Retinal fundus photograph; Remidio smartphone fundus camera: 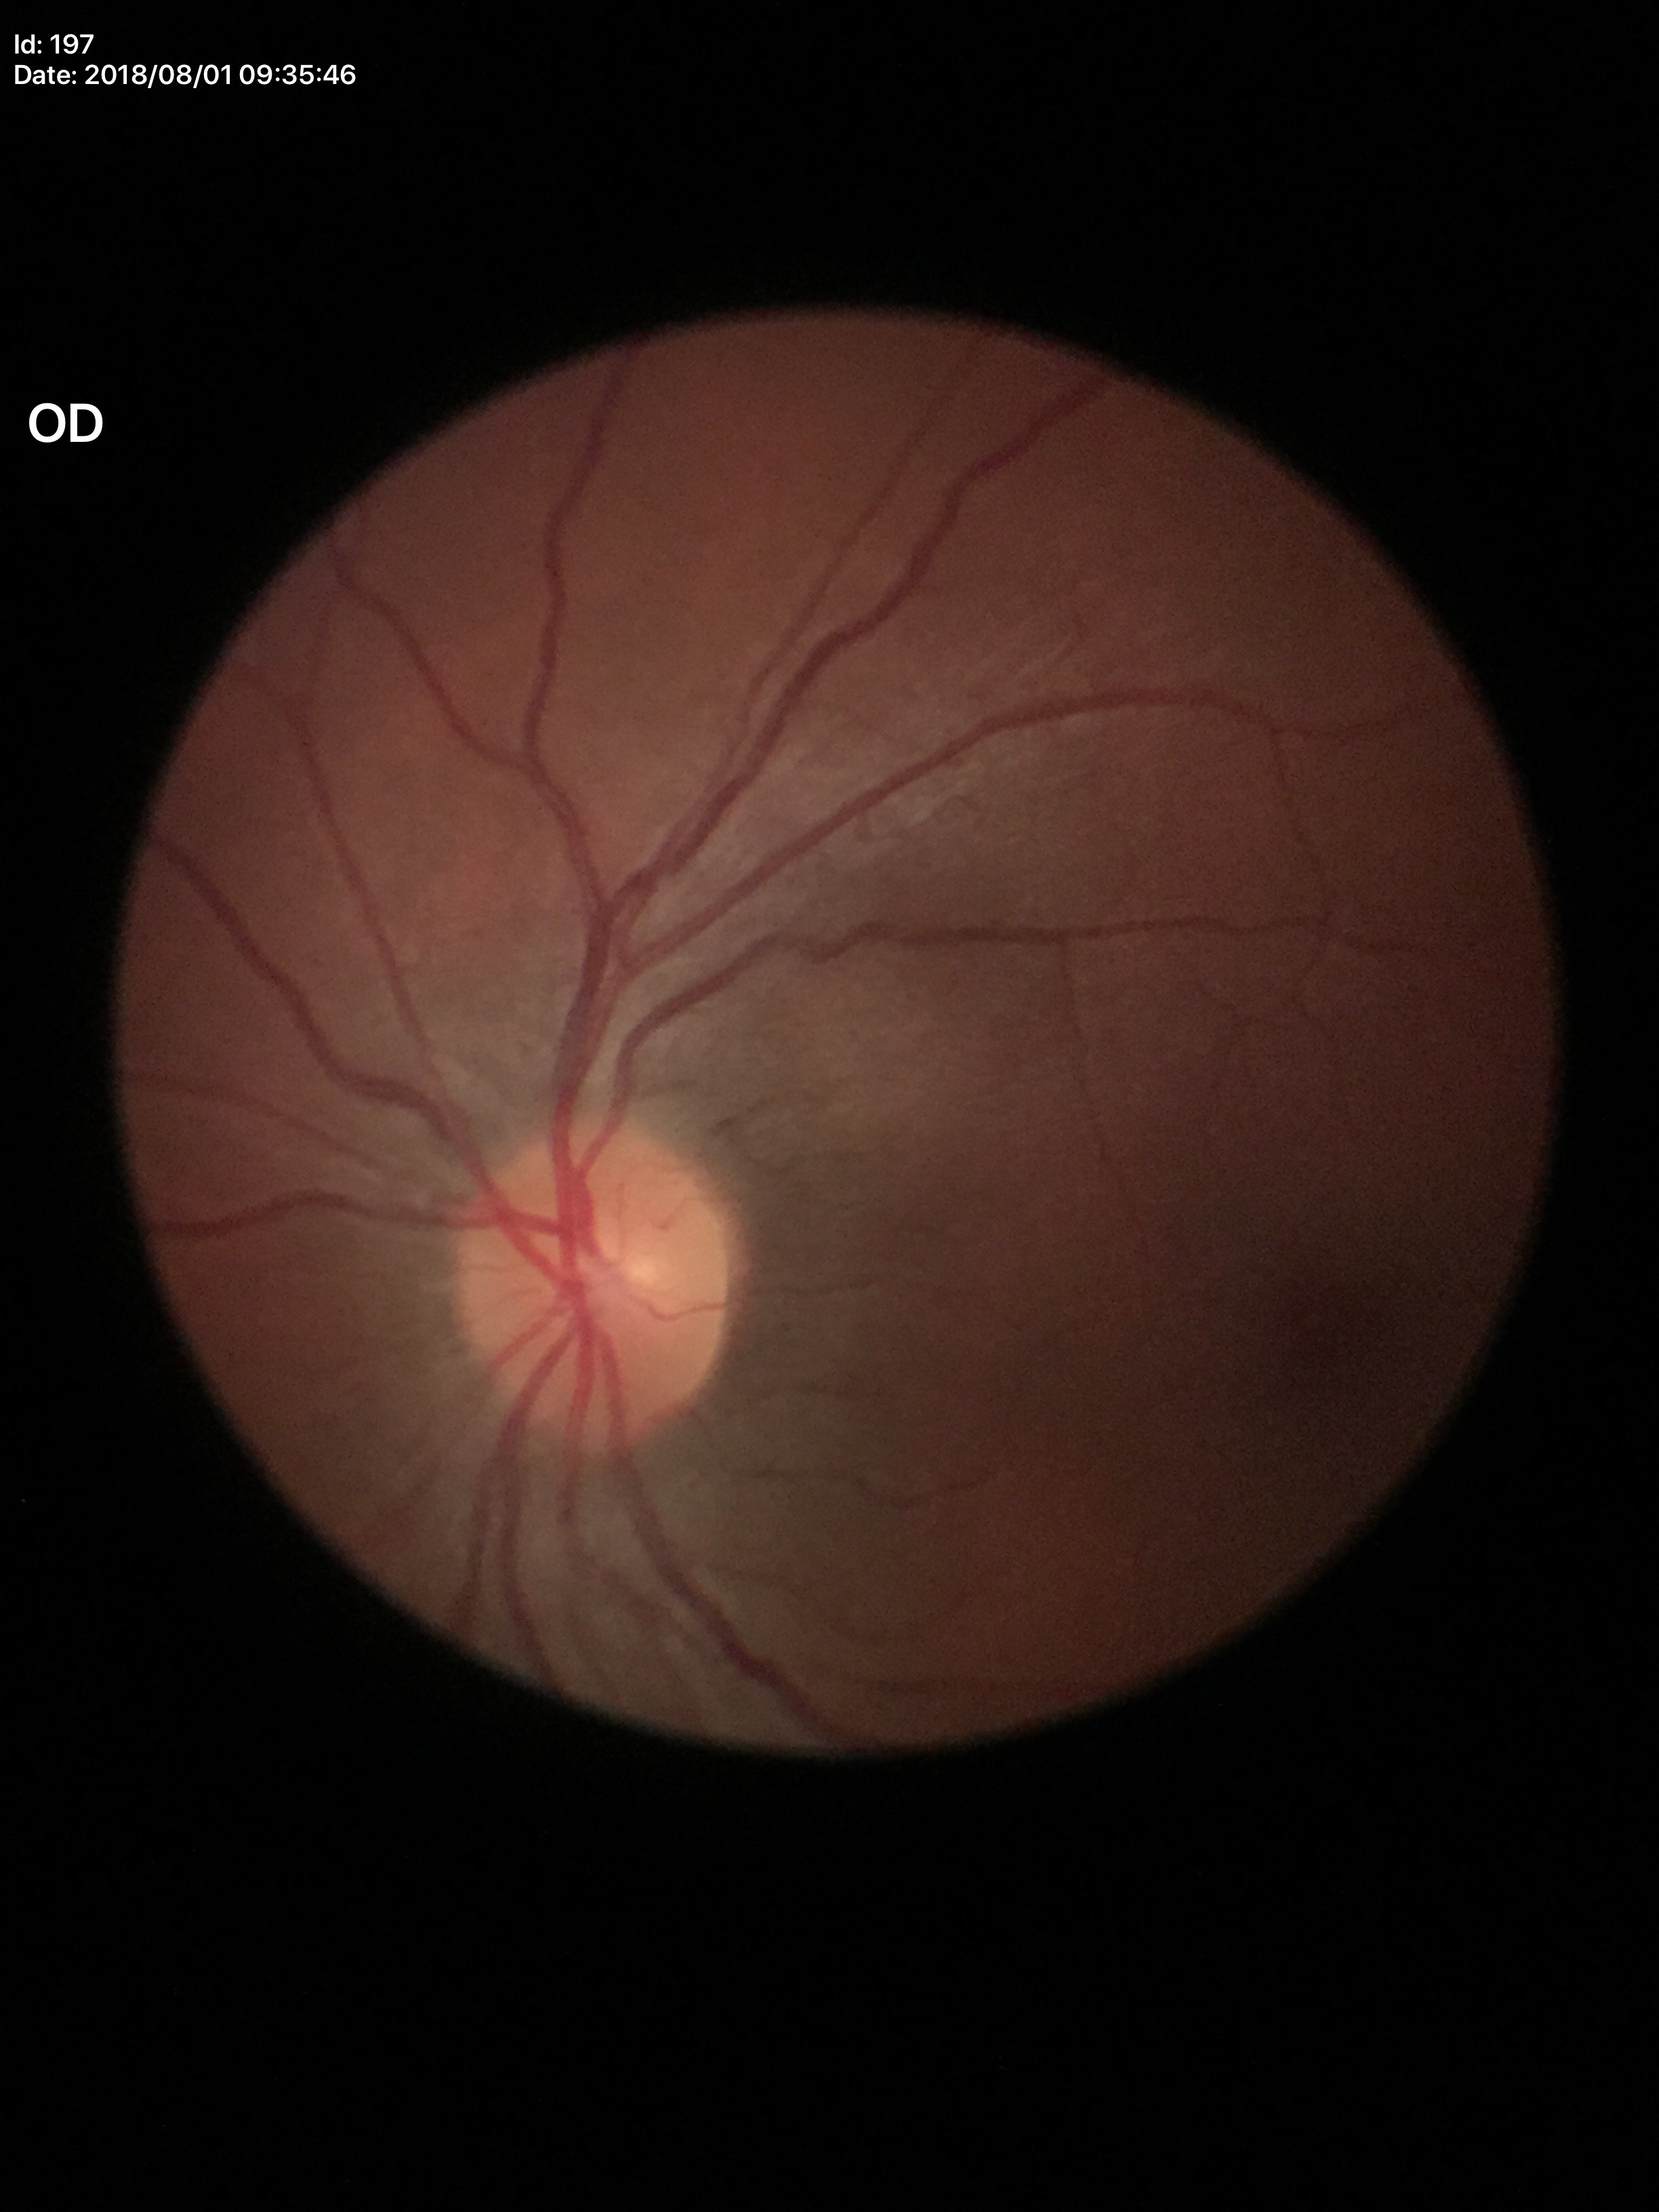

Negative for glaucoma suspicion. Vertical cup-to-disc ratio (VCDR) is 0.41. Horizontal cup-disc ratio (HCDR): 0.46.